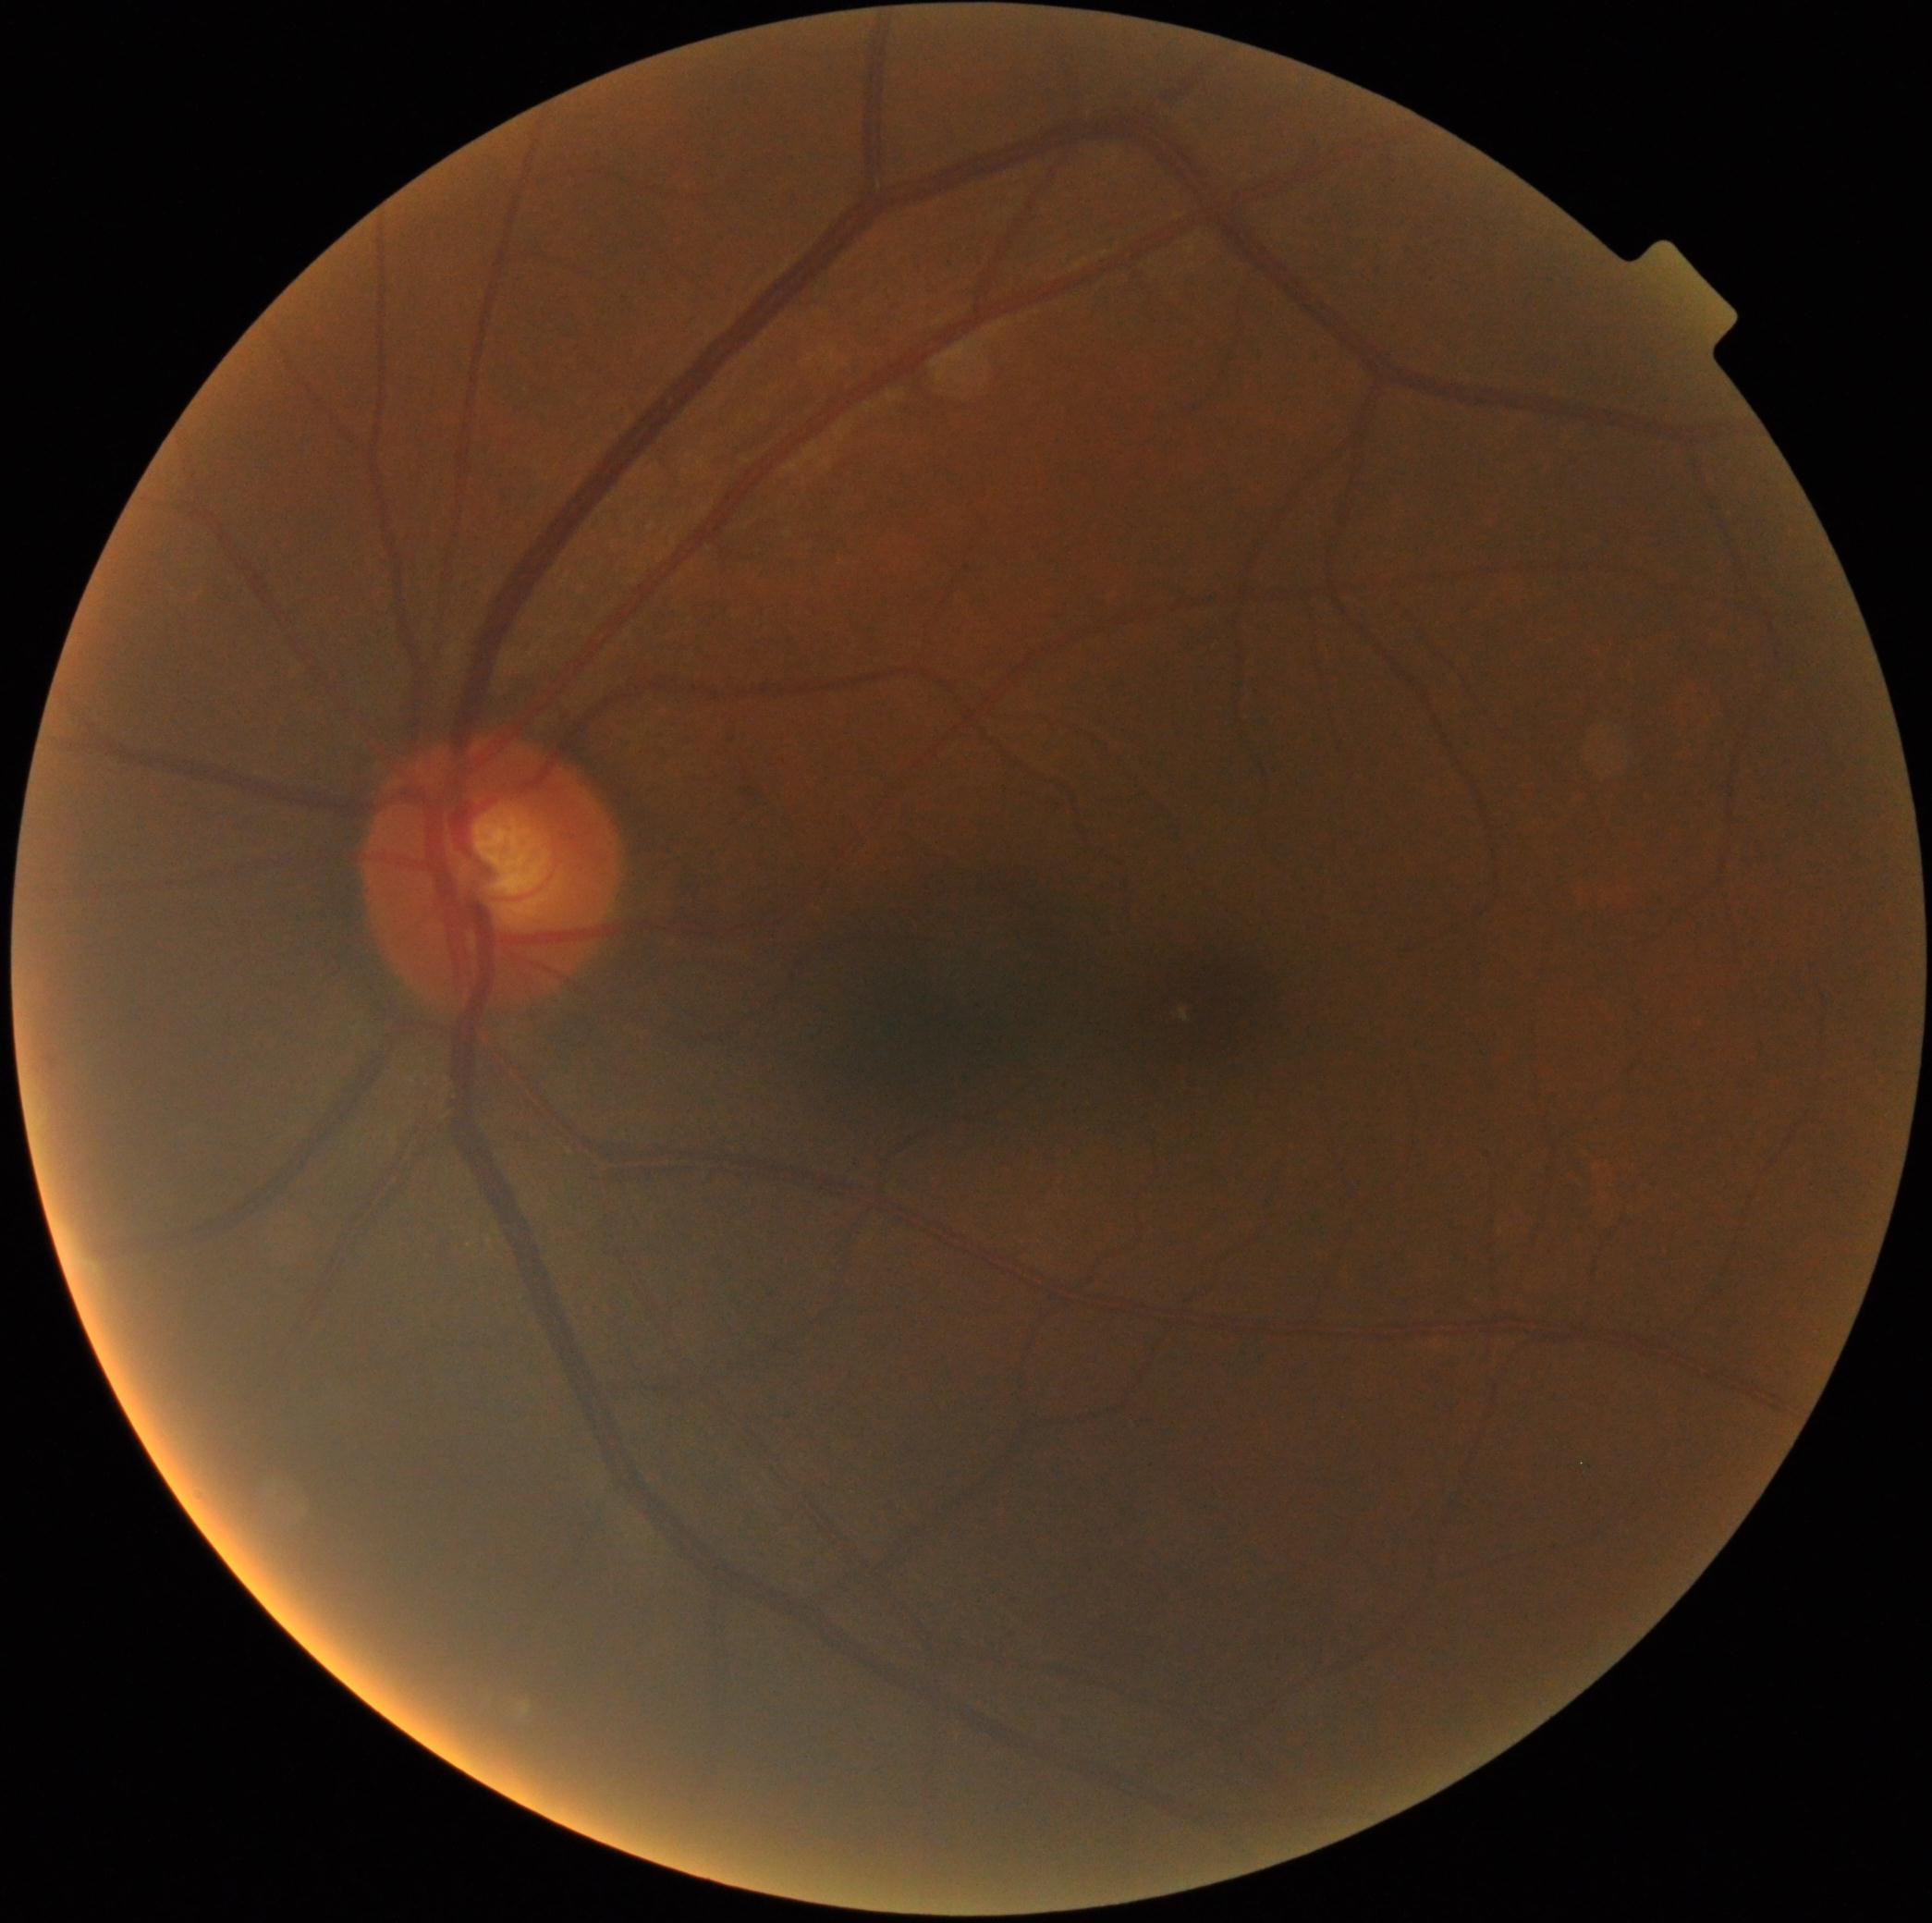

  dr_impression: no apparent DR
  dr_grade: grade 0 (no apparent retinopathy)